Fundus photo: 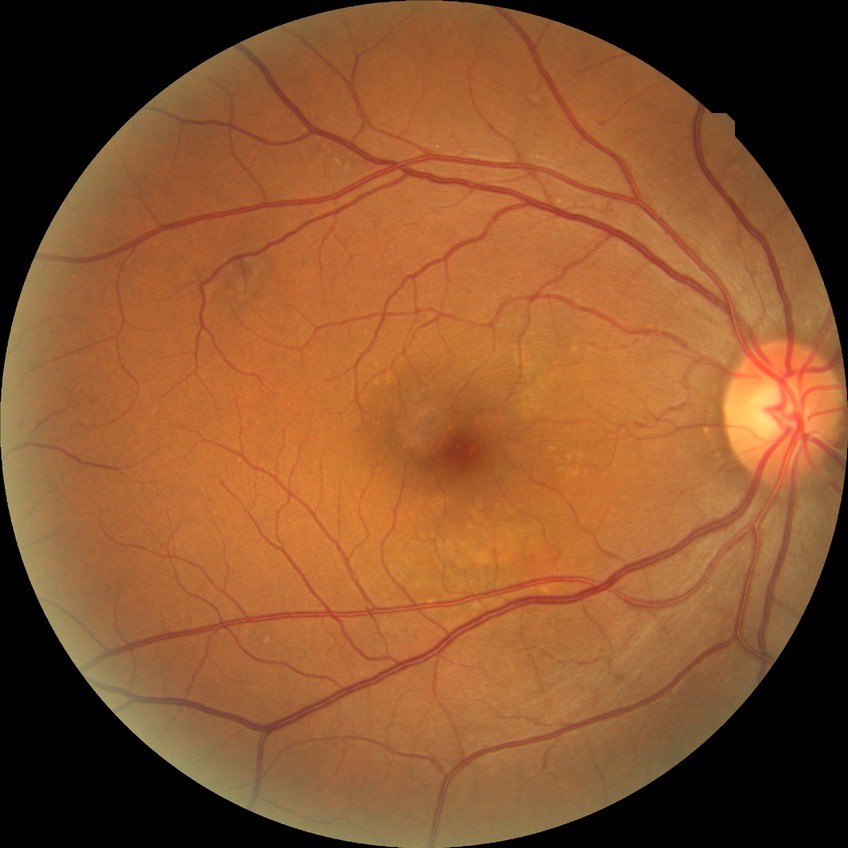

diabetic retinopathy (DR): no diabetic retinopathy (NDR).